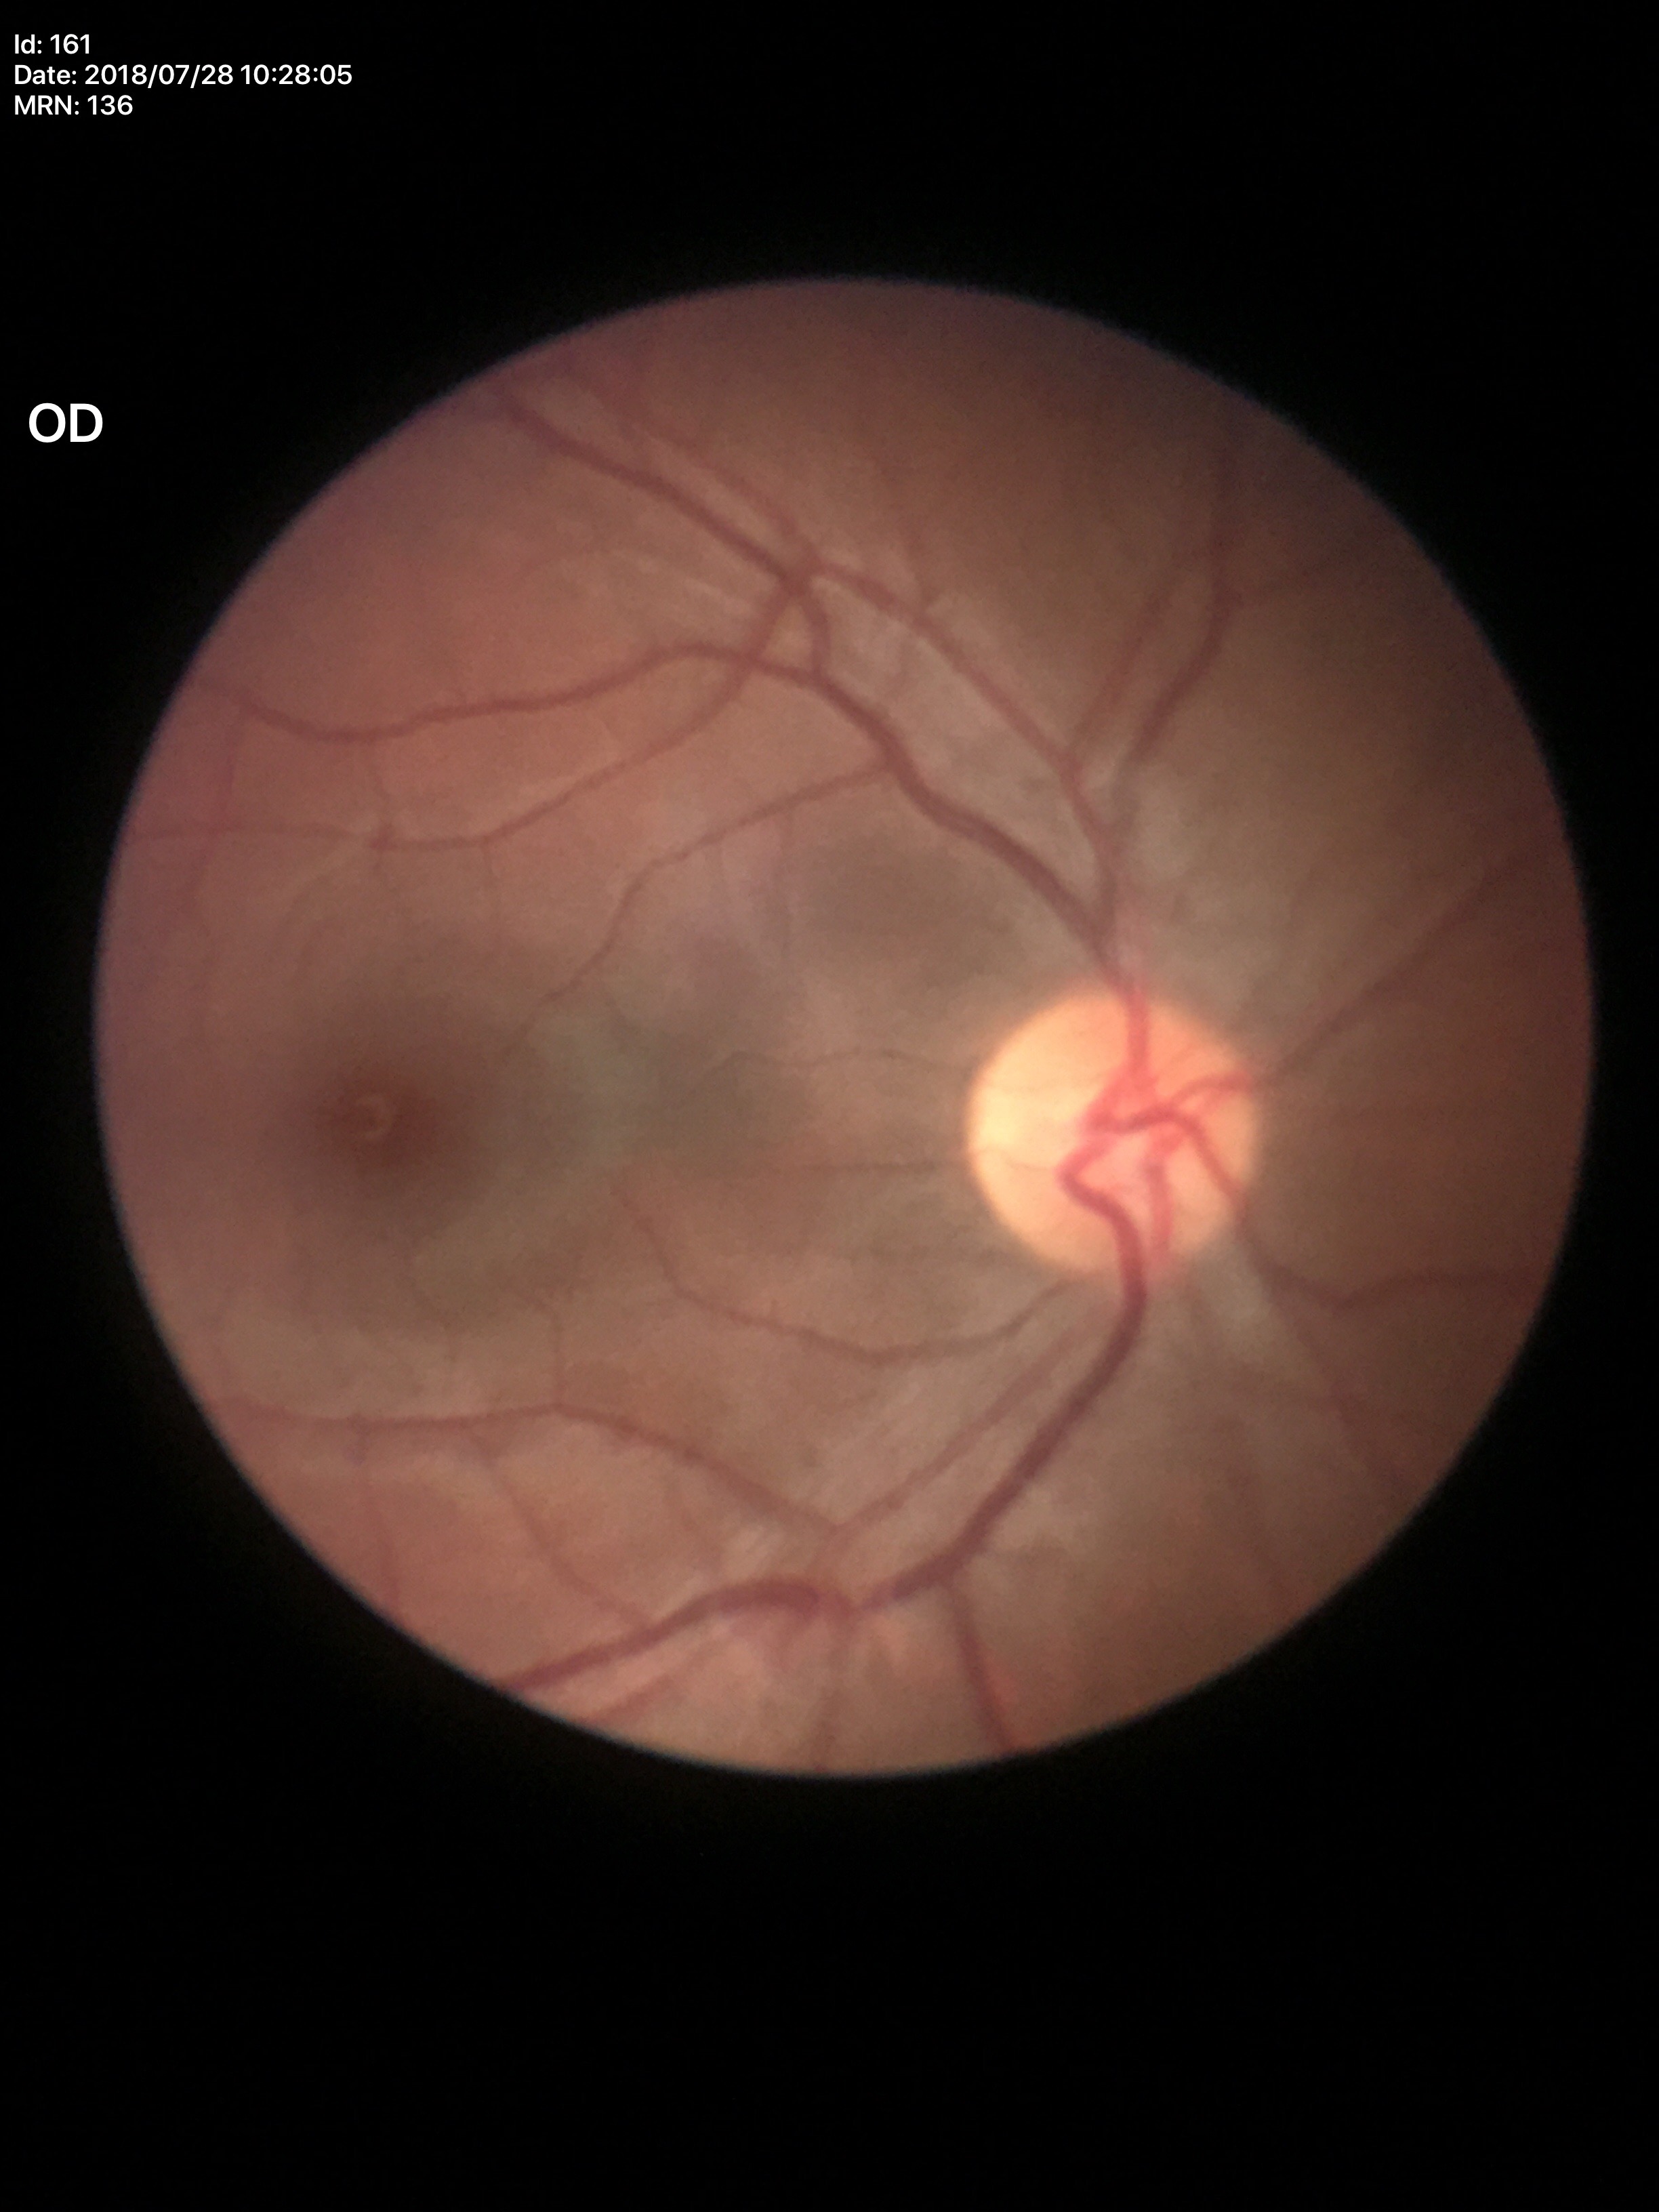
No glaucomatous findings (5/5 ophthalmologists in agreement). Vertical C/D ratio (VCDR) is 0.47.